Diabetic retinopathy graded by the modified Davis classification.
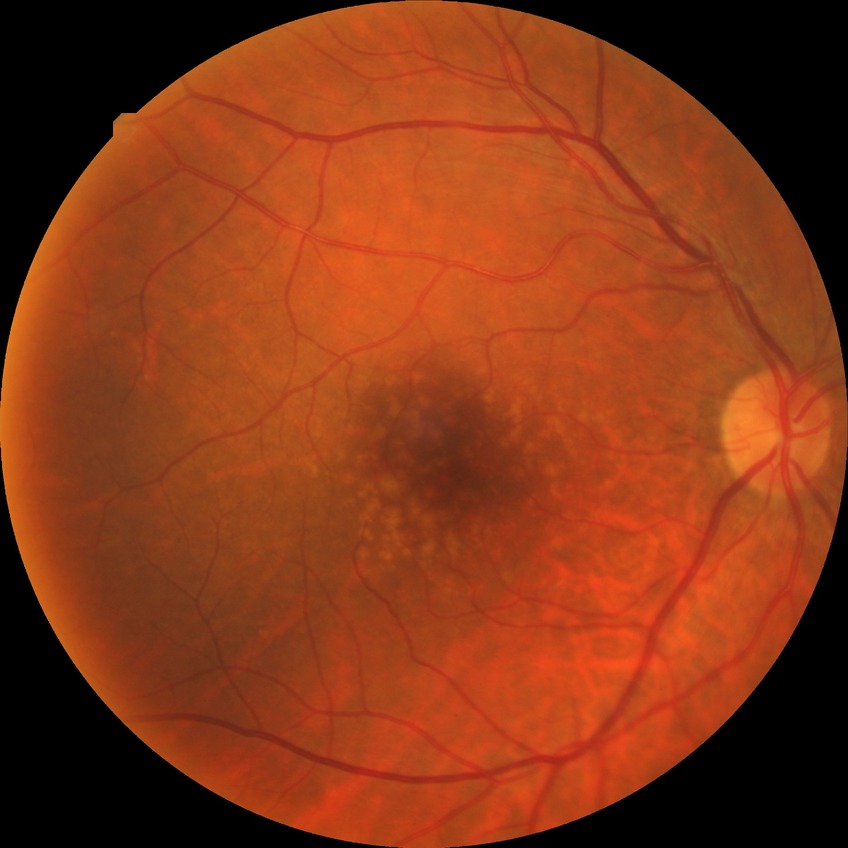 No signs of diabetic retinopathy. DR stage: NDR.